Wide-field fundus photograph of an infant. Acquired on the Clarity RetCam 3: 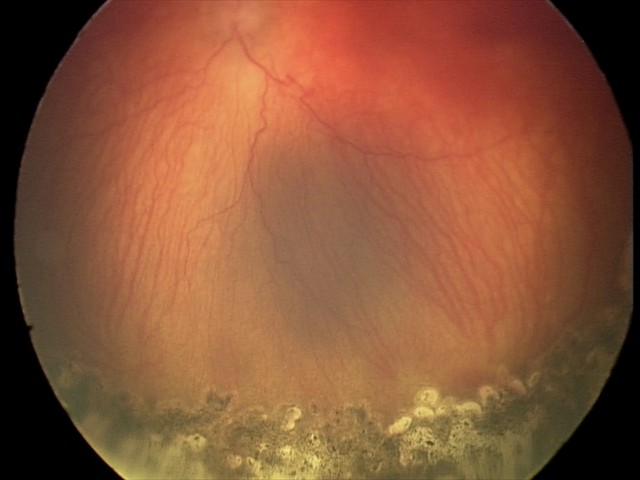

Examination diagnosed as aggressive retinopathy of prematurity.
With plus disease.